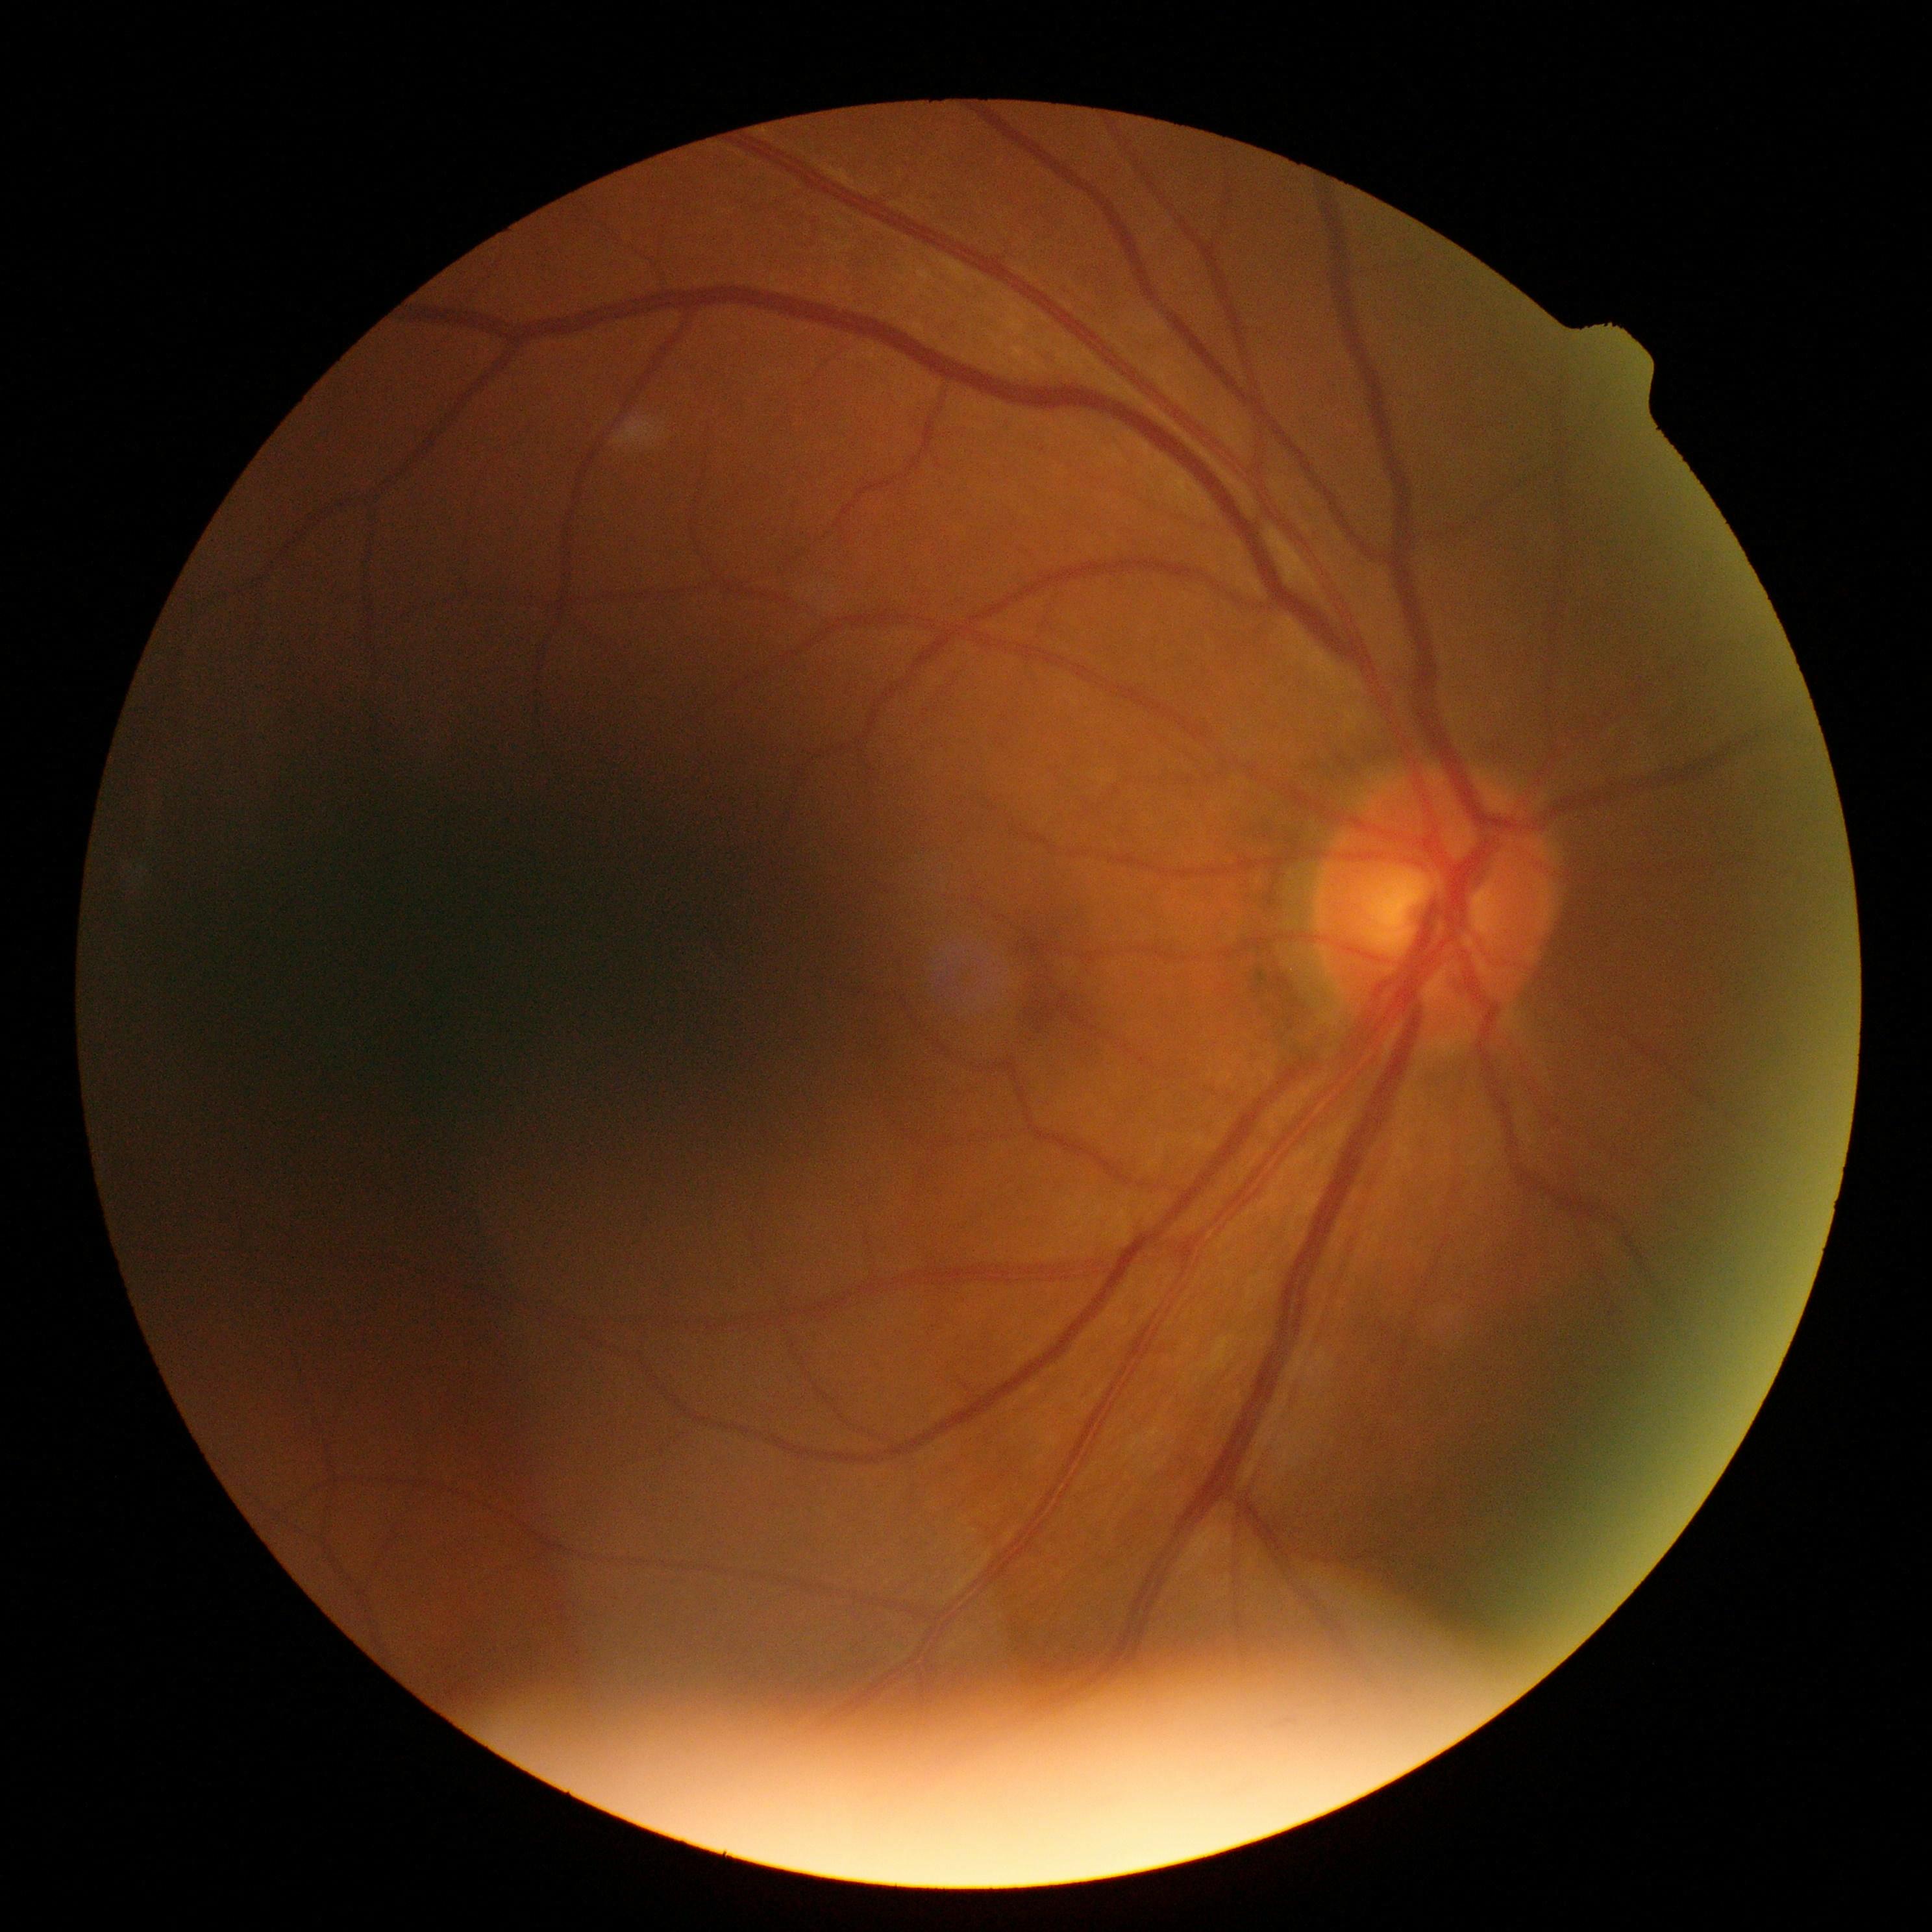

DR grade = 0 (no apparent retinopathy) — no visible signs of diabetic retinopathy.